Modified Davis classification, 848 by 848 pixels:
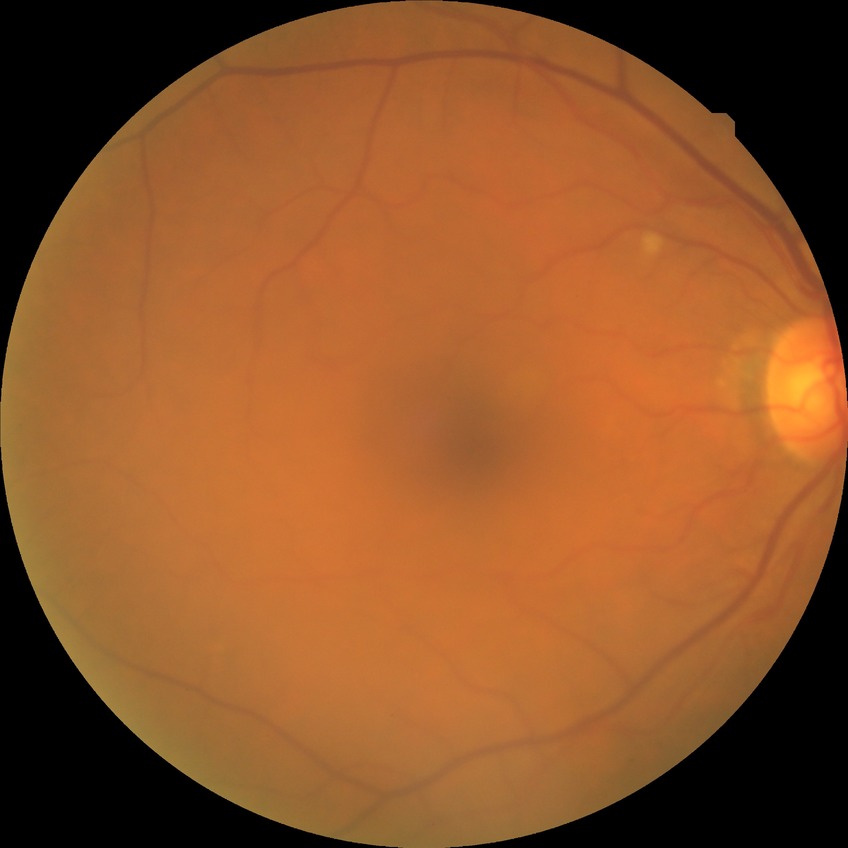

Assessment:
* diabetic retinopathy grade — no diabetic retinopathy